Infant wide-field fundus photograph. Image size 1240x1240 — 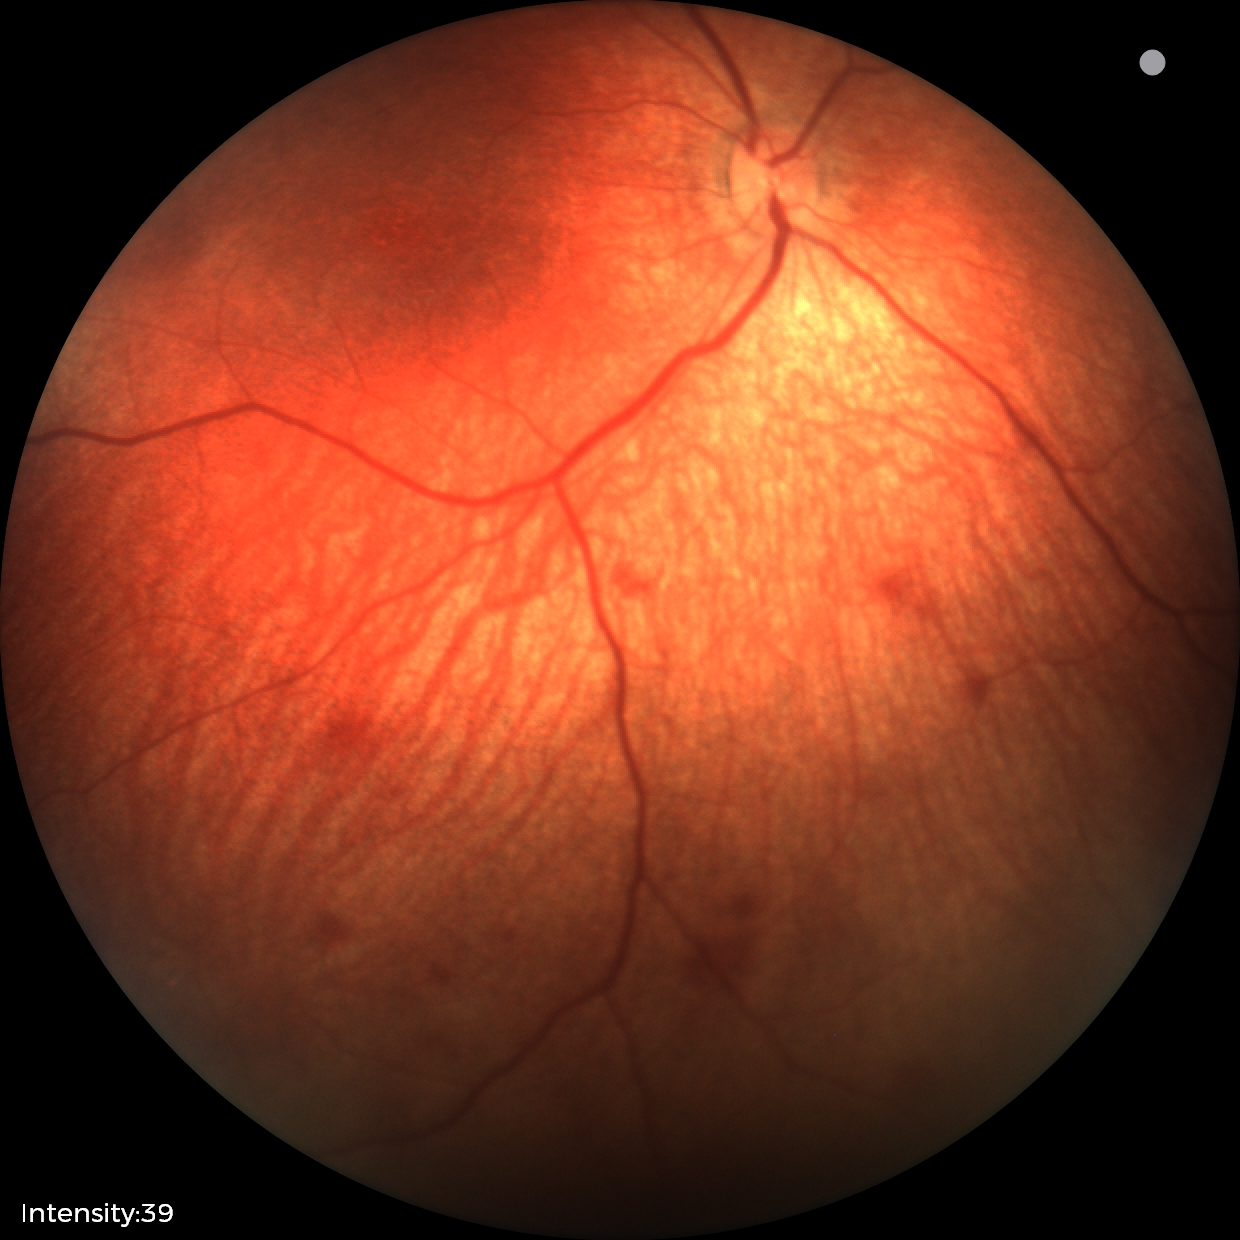 Screening examination consistent with retinal hemorrhages.